2352x1568px: 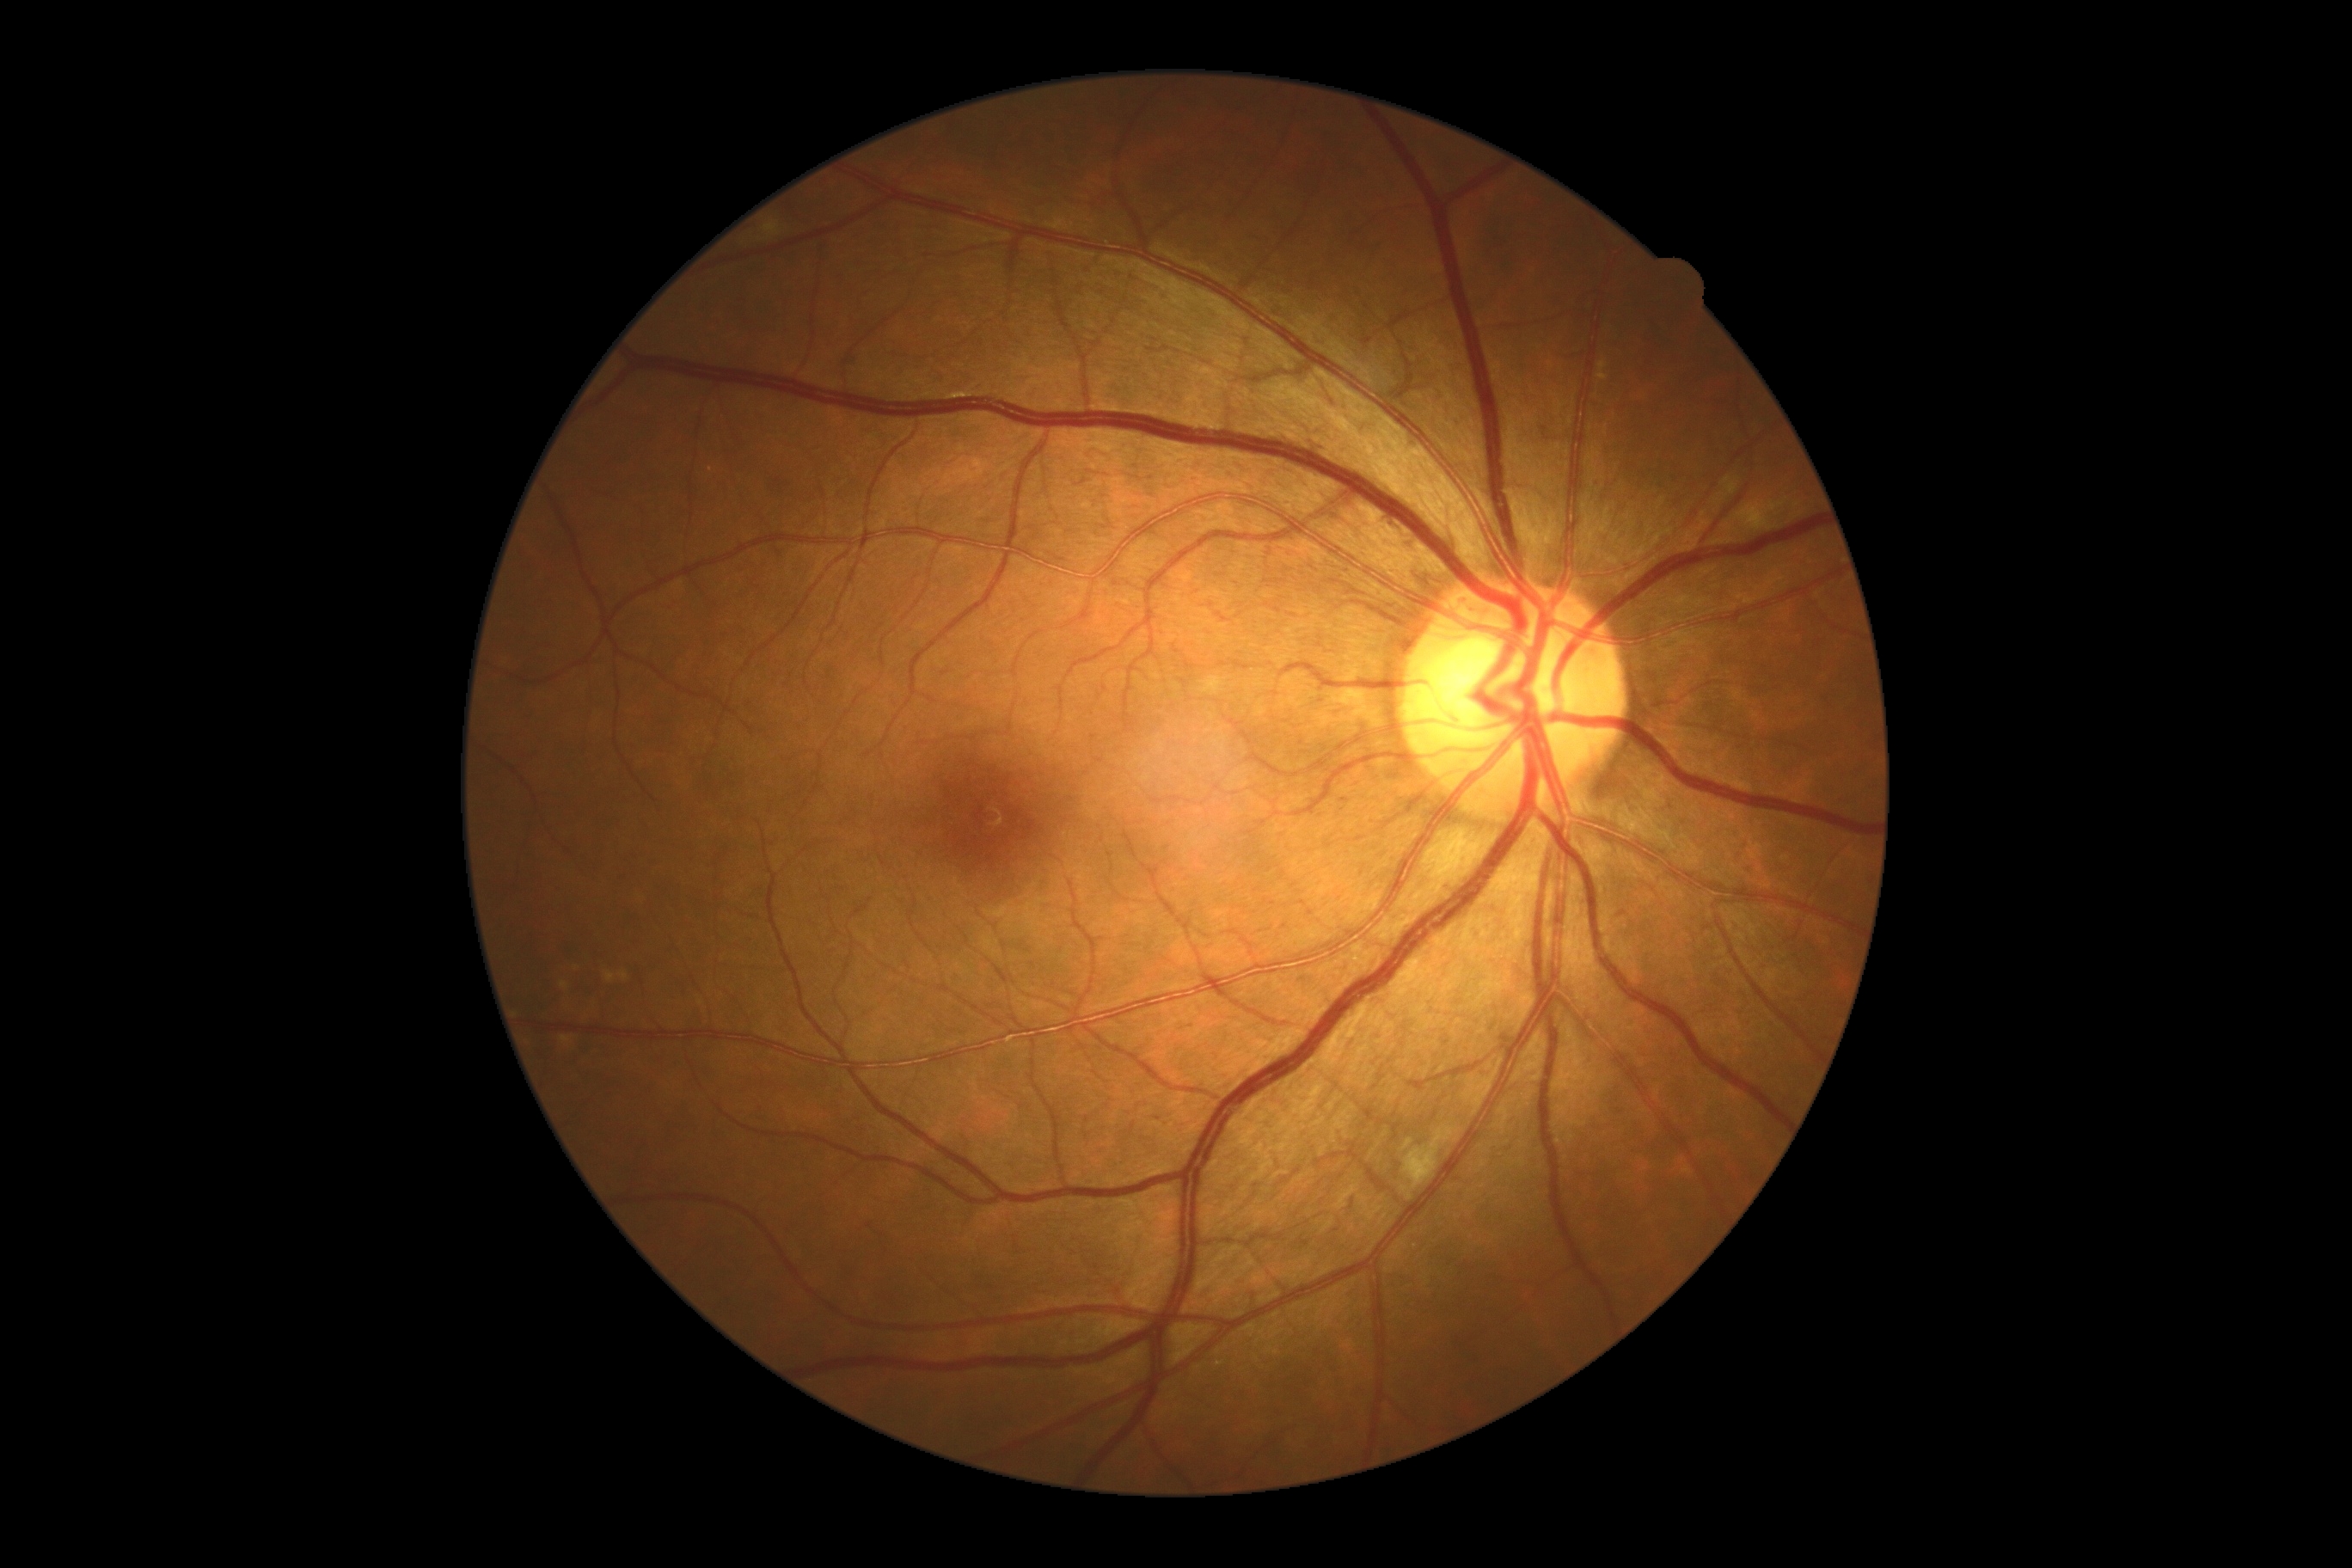

DR stage@2/4 — more than just microaneurysms but less than severe NPDR; DR class@non-proliferative diabetic retinopathy.